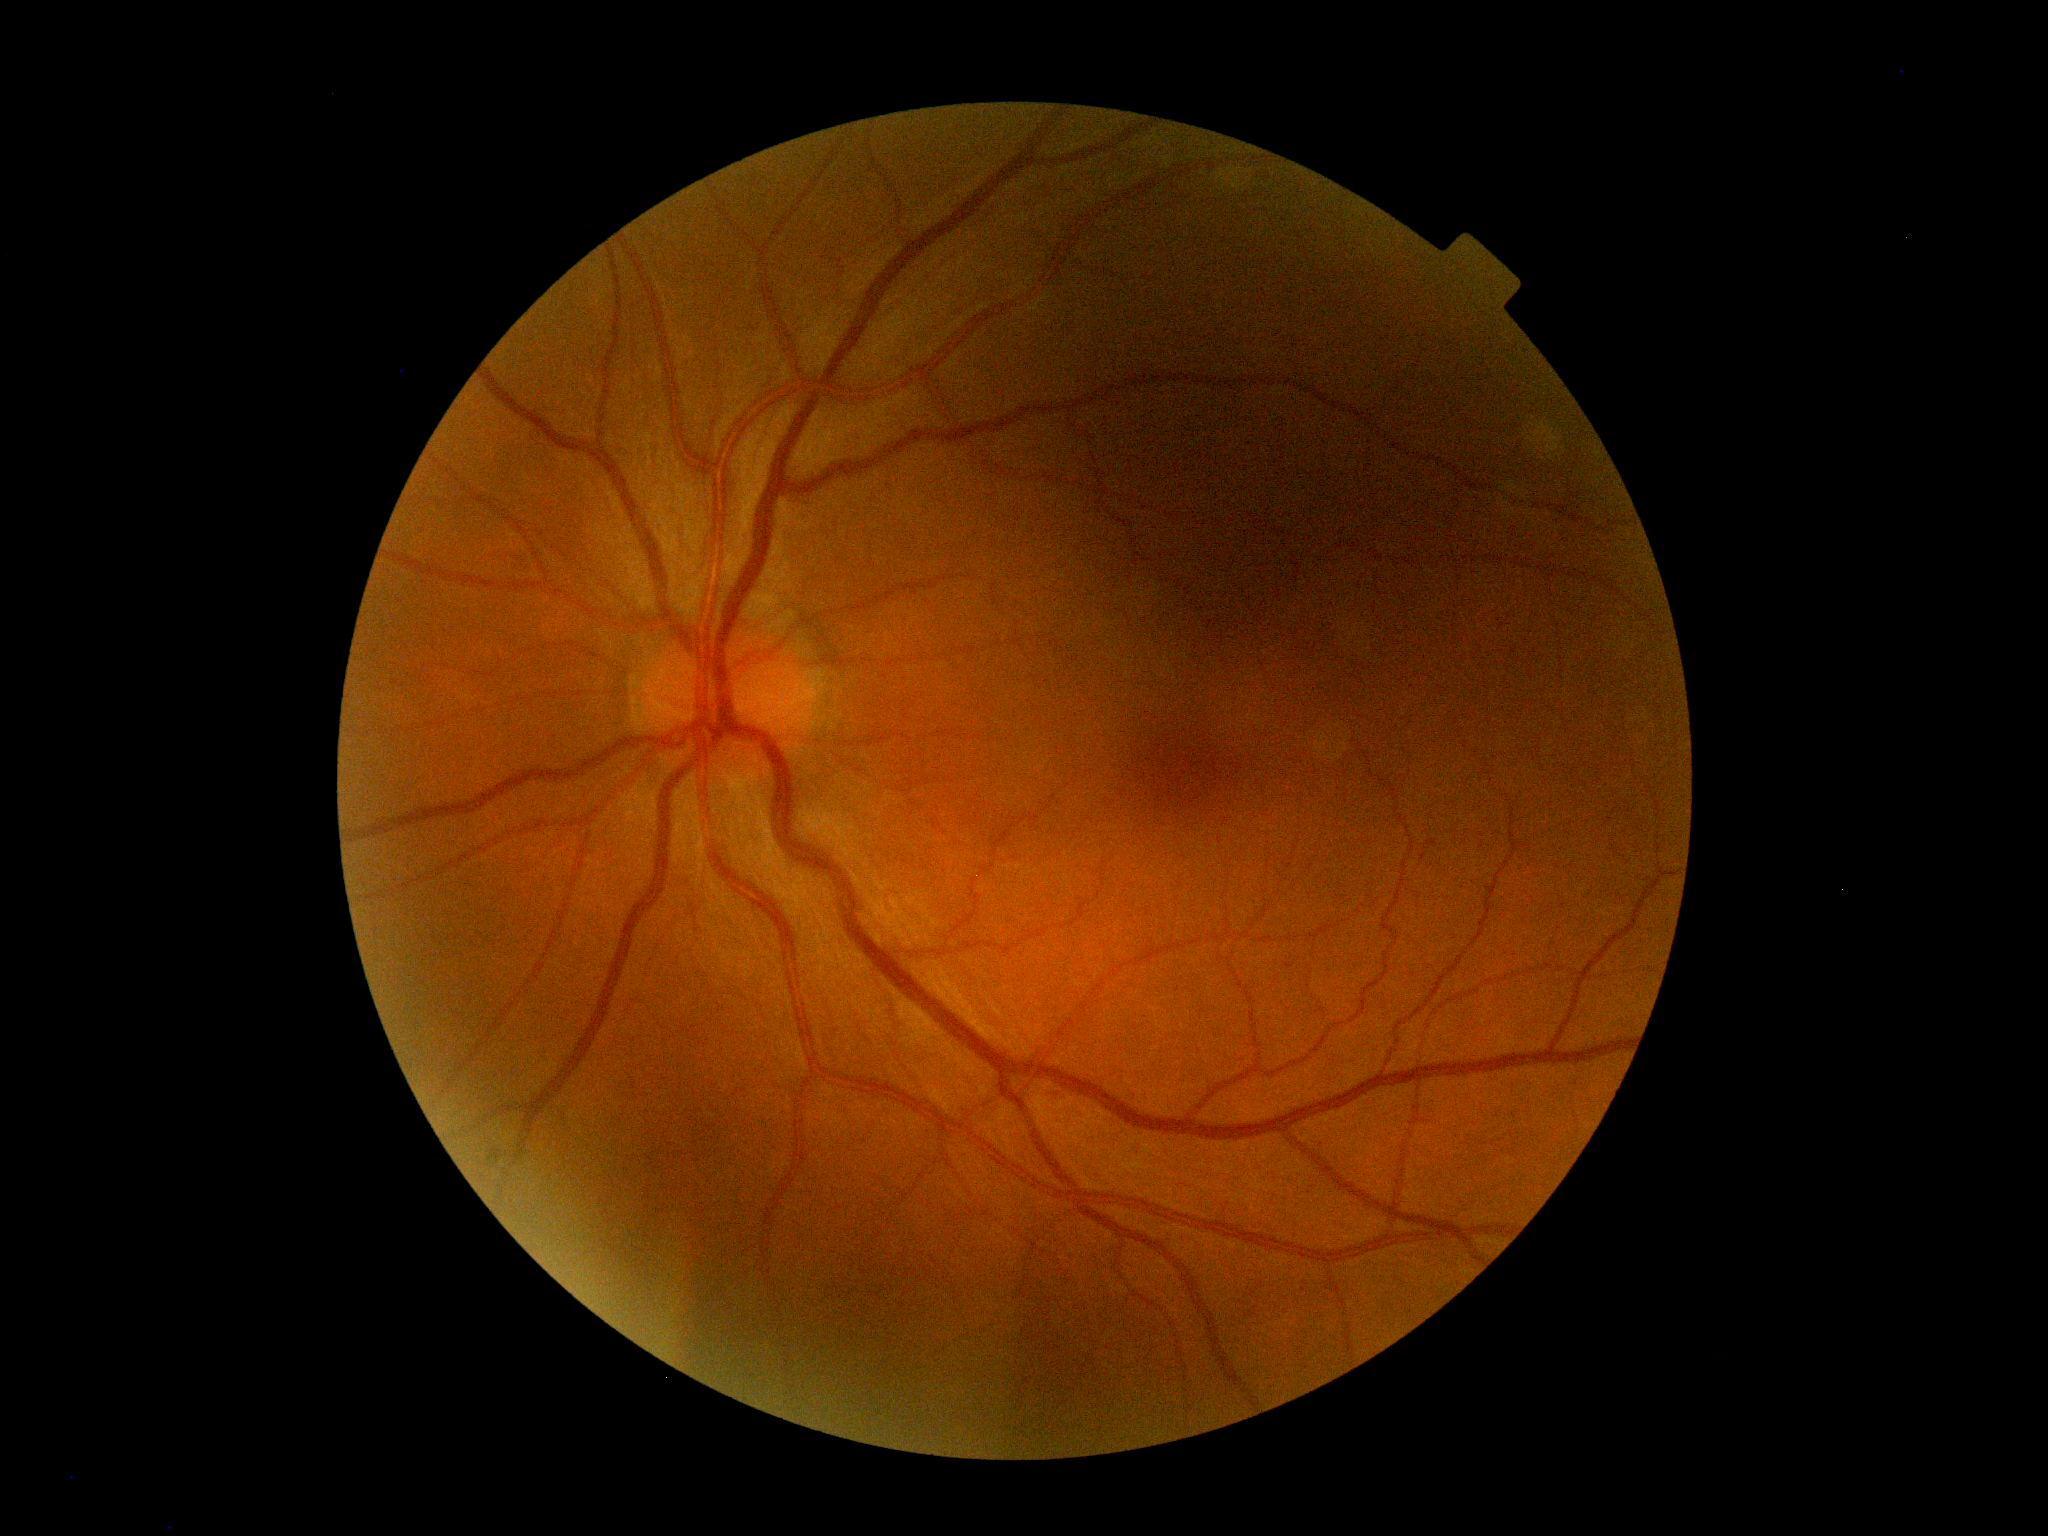

Findings:
- diabetic retinopathy: no apparent retinopathy (grade 0)